45° FOV: 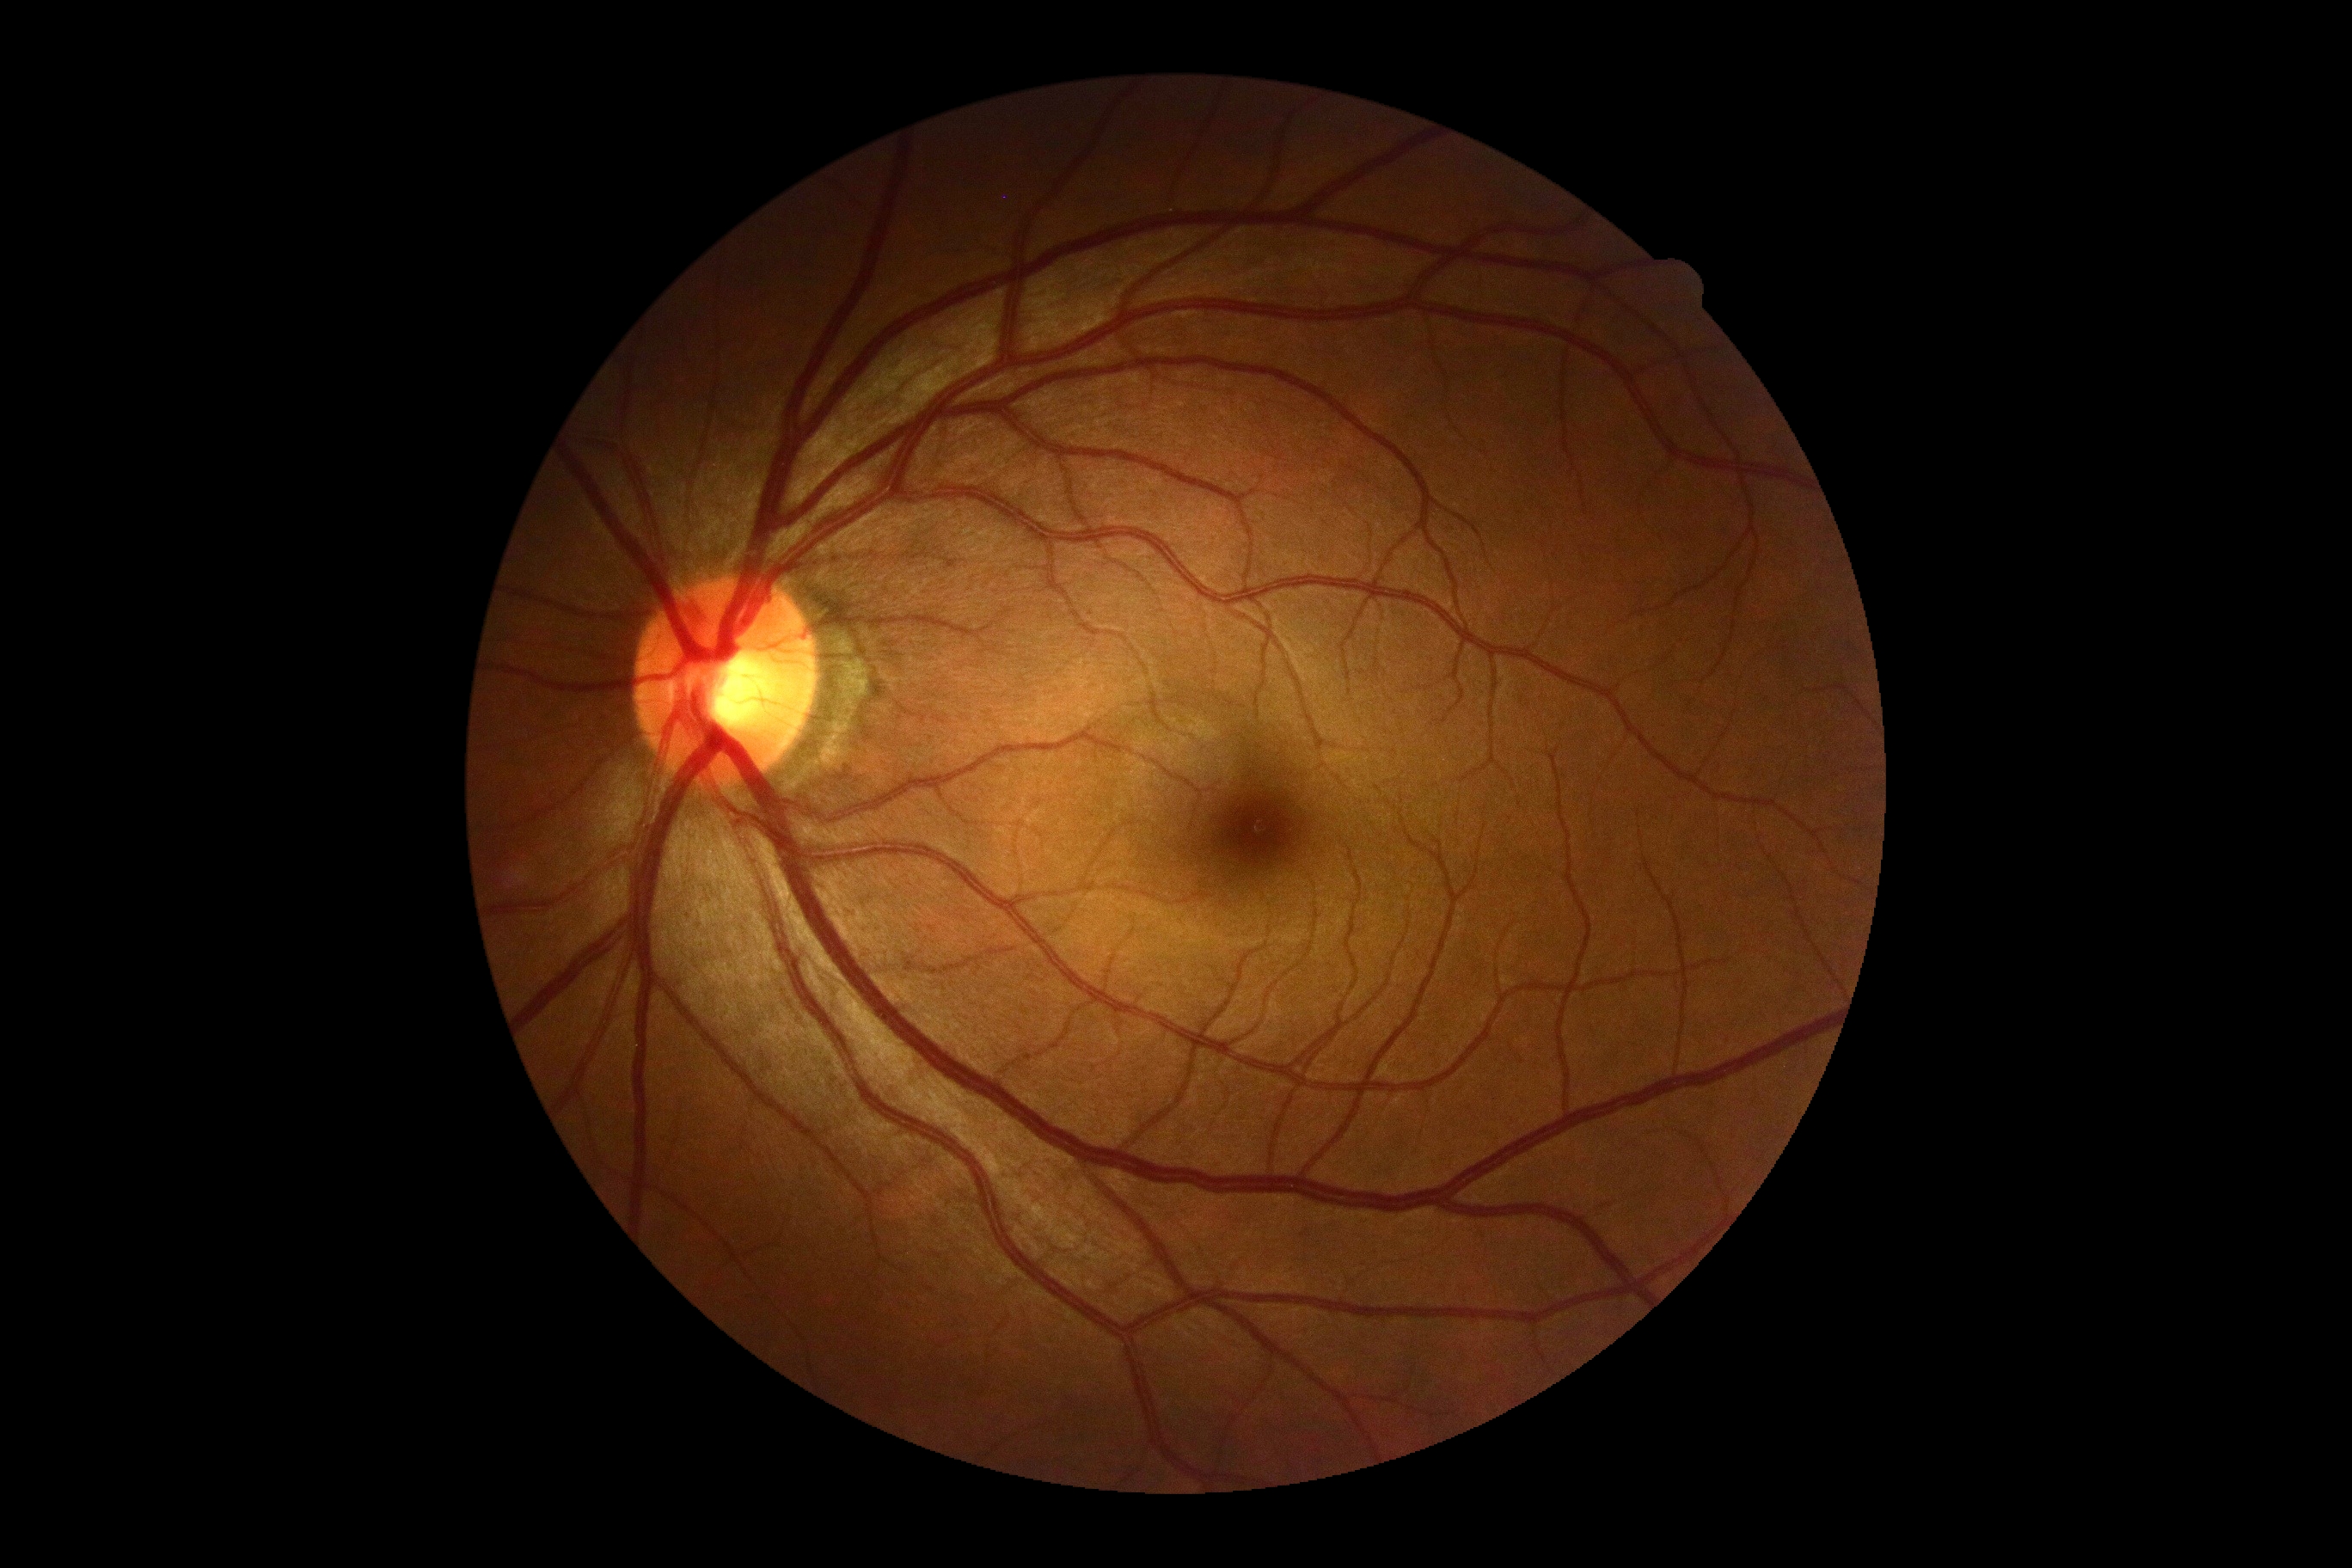
No apparent diabetic retinopathy. Diabetic retinopathy: grade 0.